848x848px · diabetic retinopathy graded by the modified Davis classification — 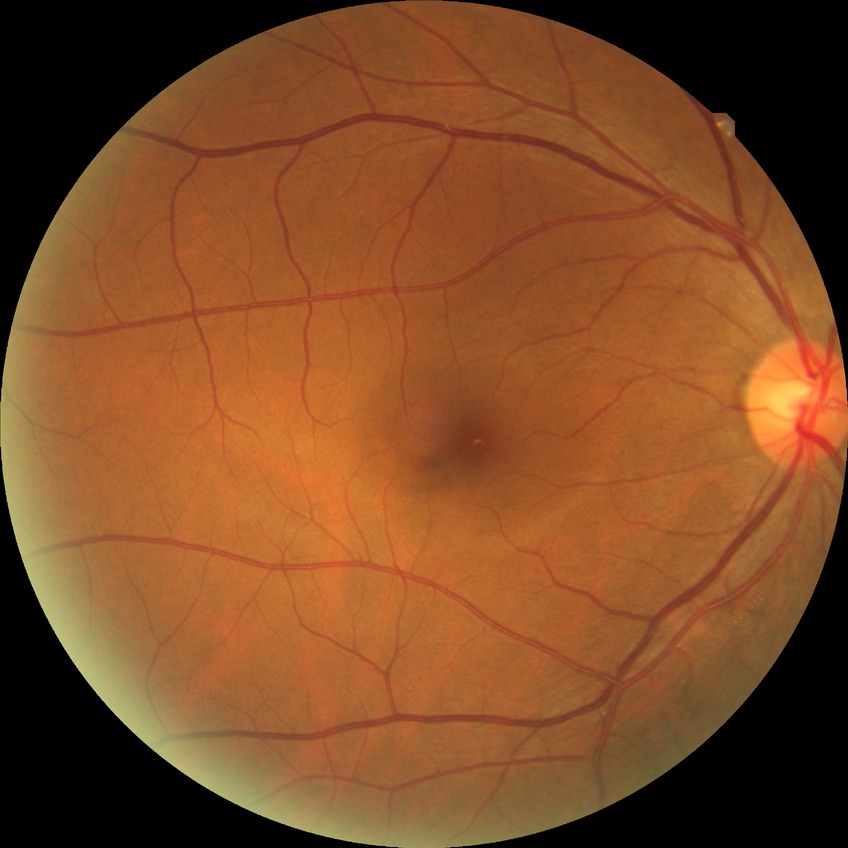
{
  "davis_grade": "NDR"
}